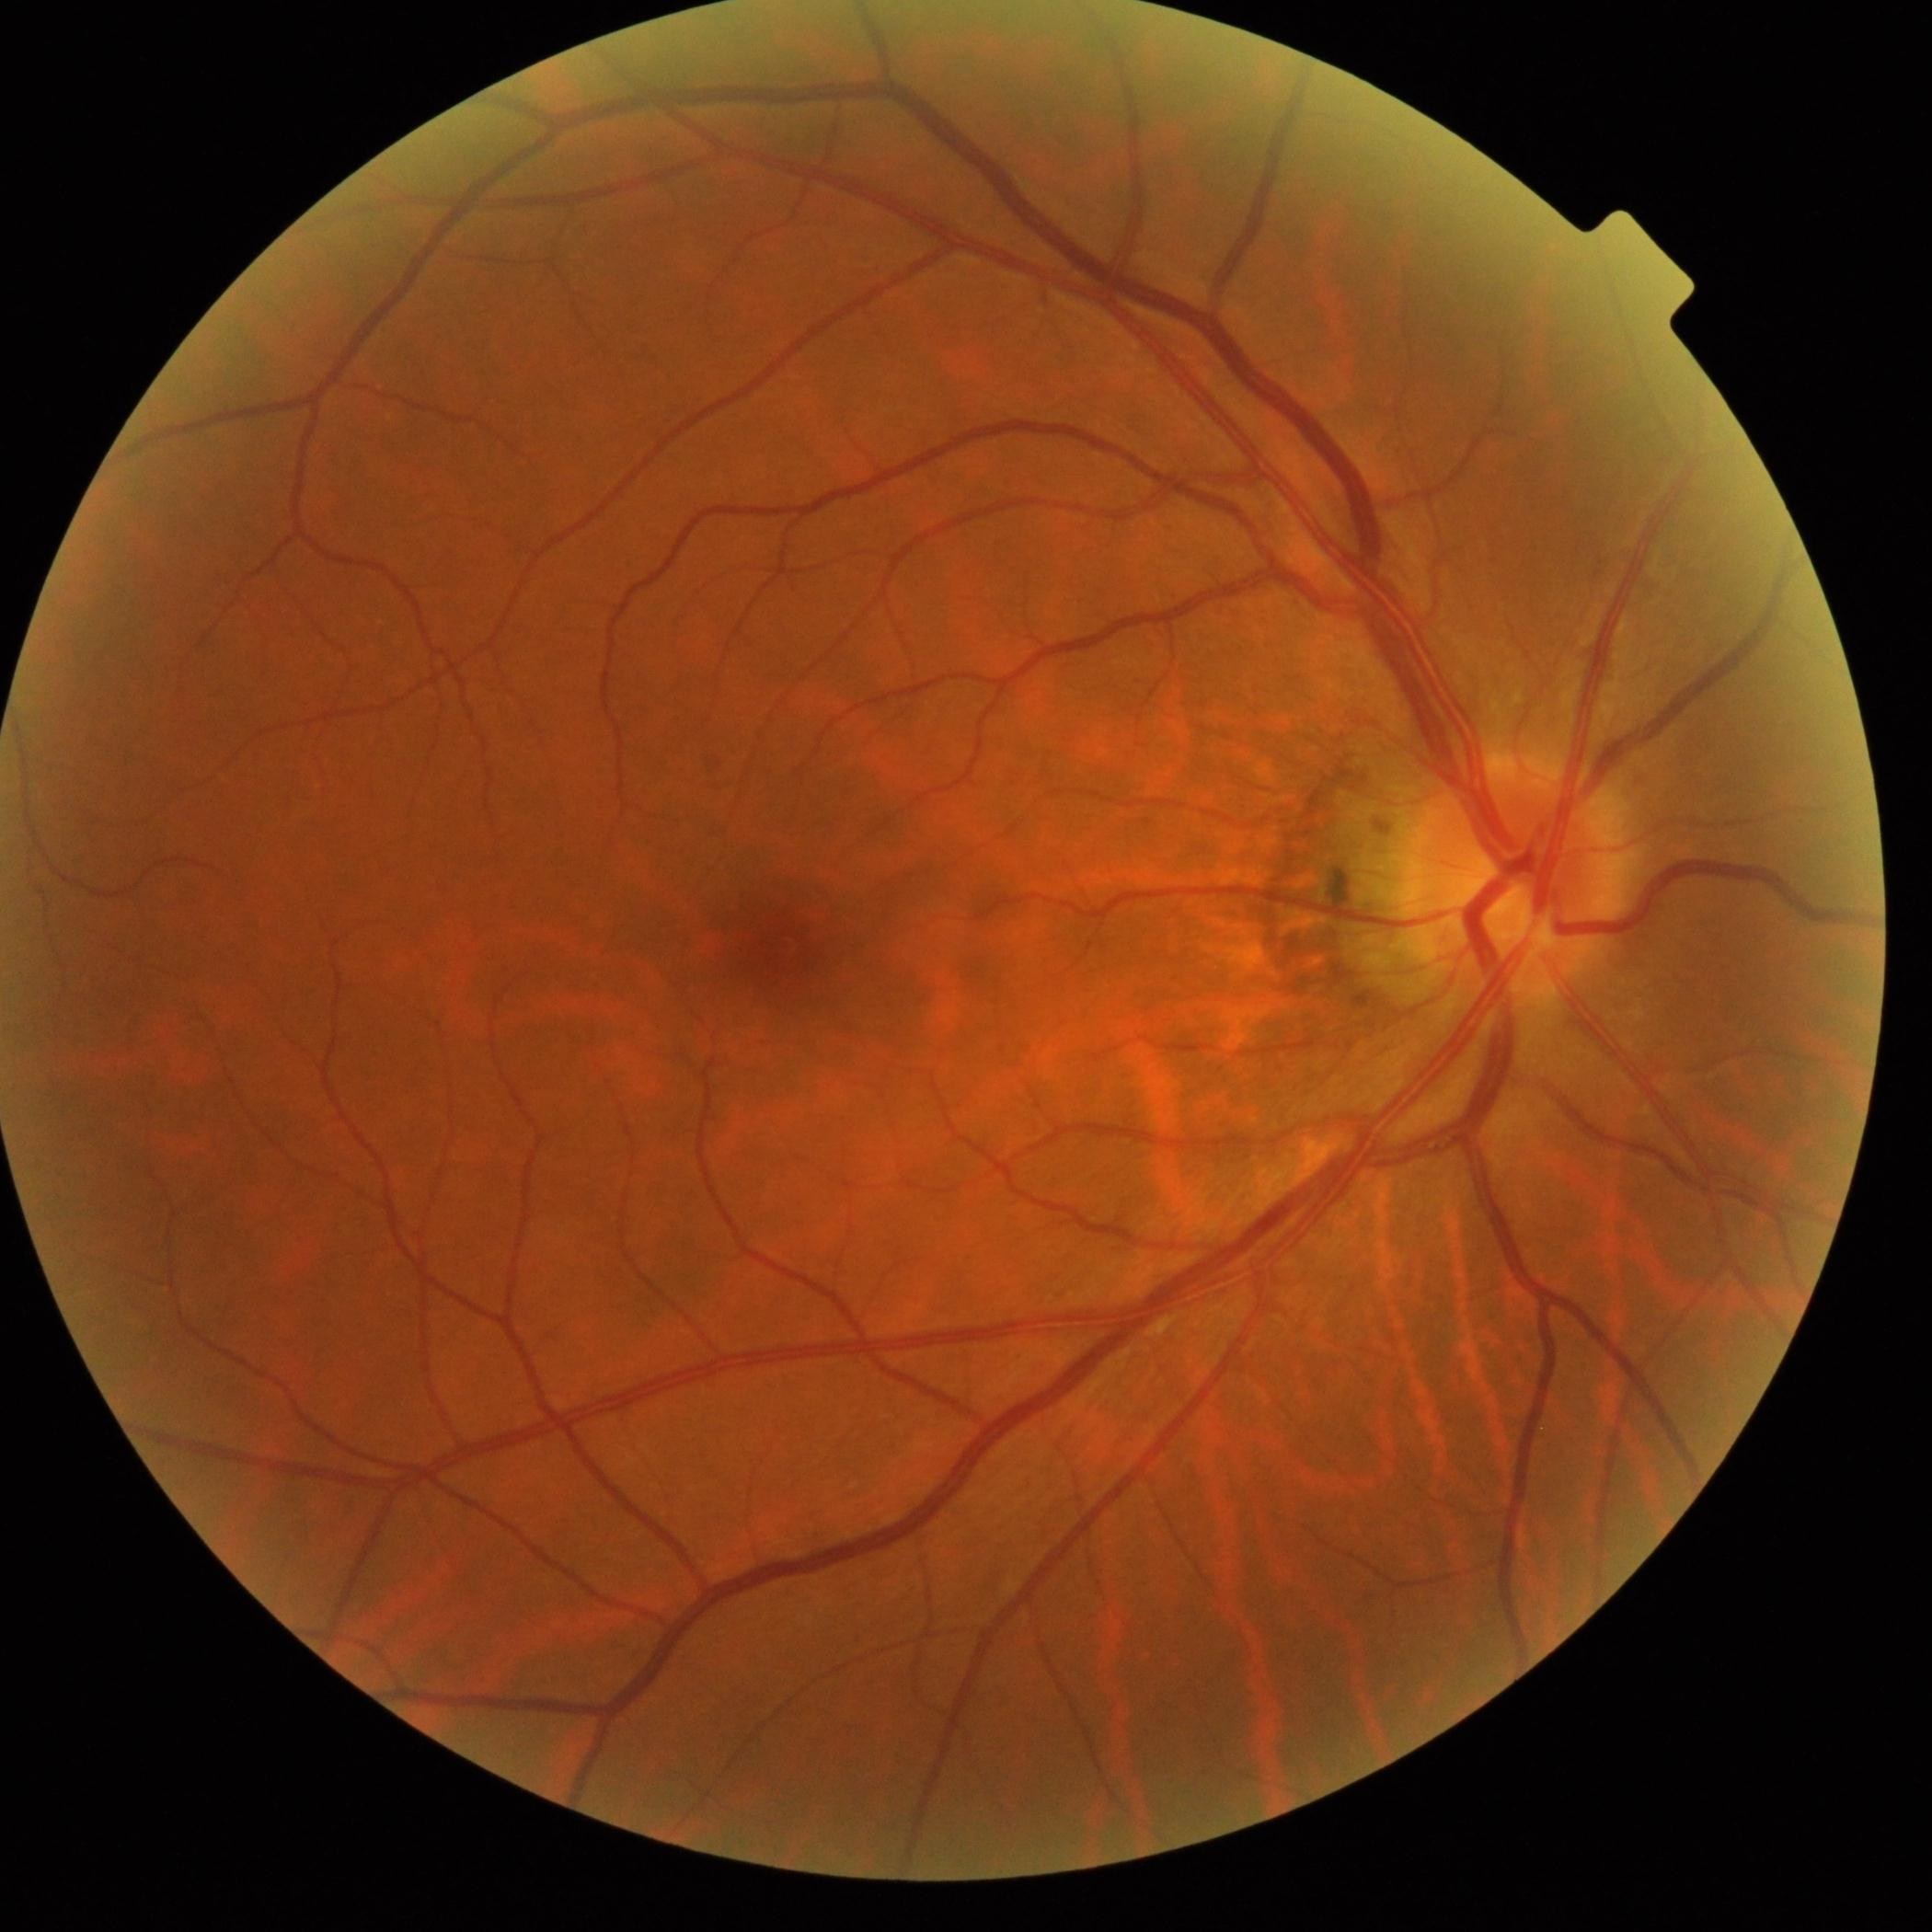 DR grade = 0.